45 degree fundus photograph. NIDEK AFC-230 fundus camera: 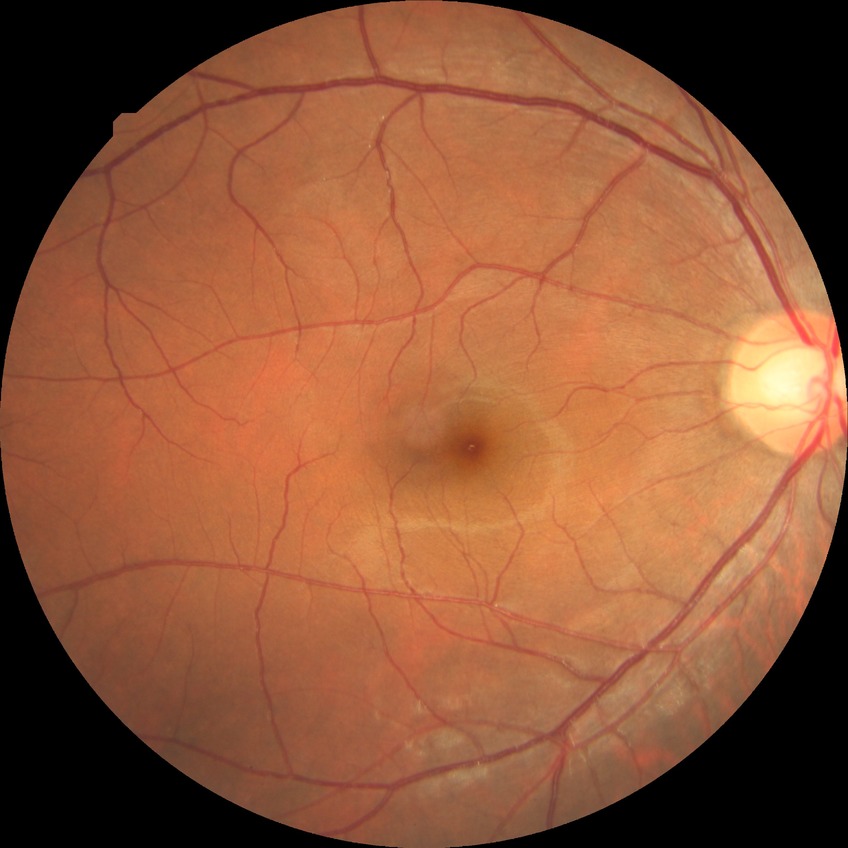

Diabetic retinopathy (DR): NDR (no diabetic retinopathy).